Modified Davis classification
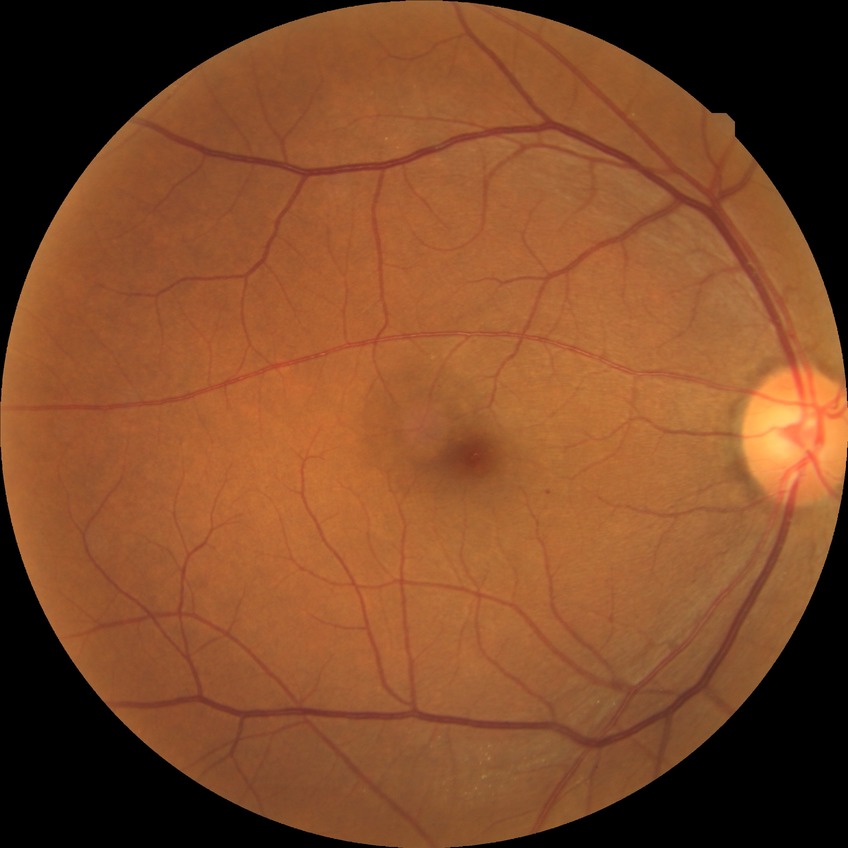

Diabetic retinopathy (DR) is no diabetic retinopathy (NDR).